45° FOV.
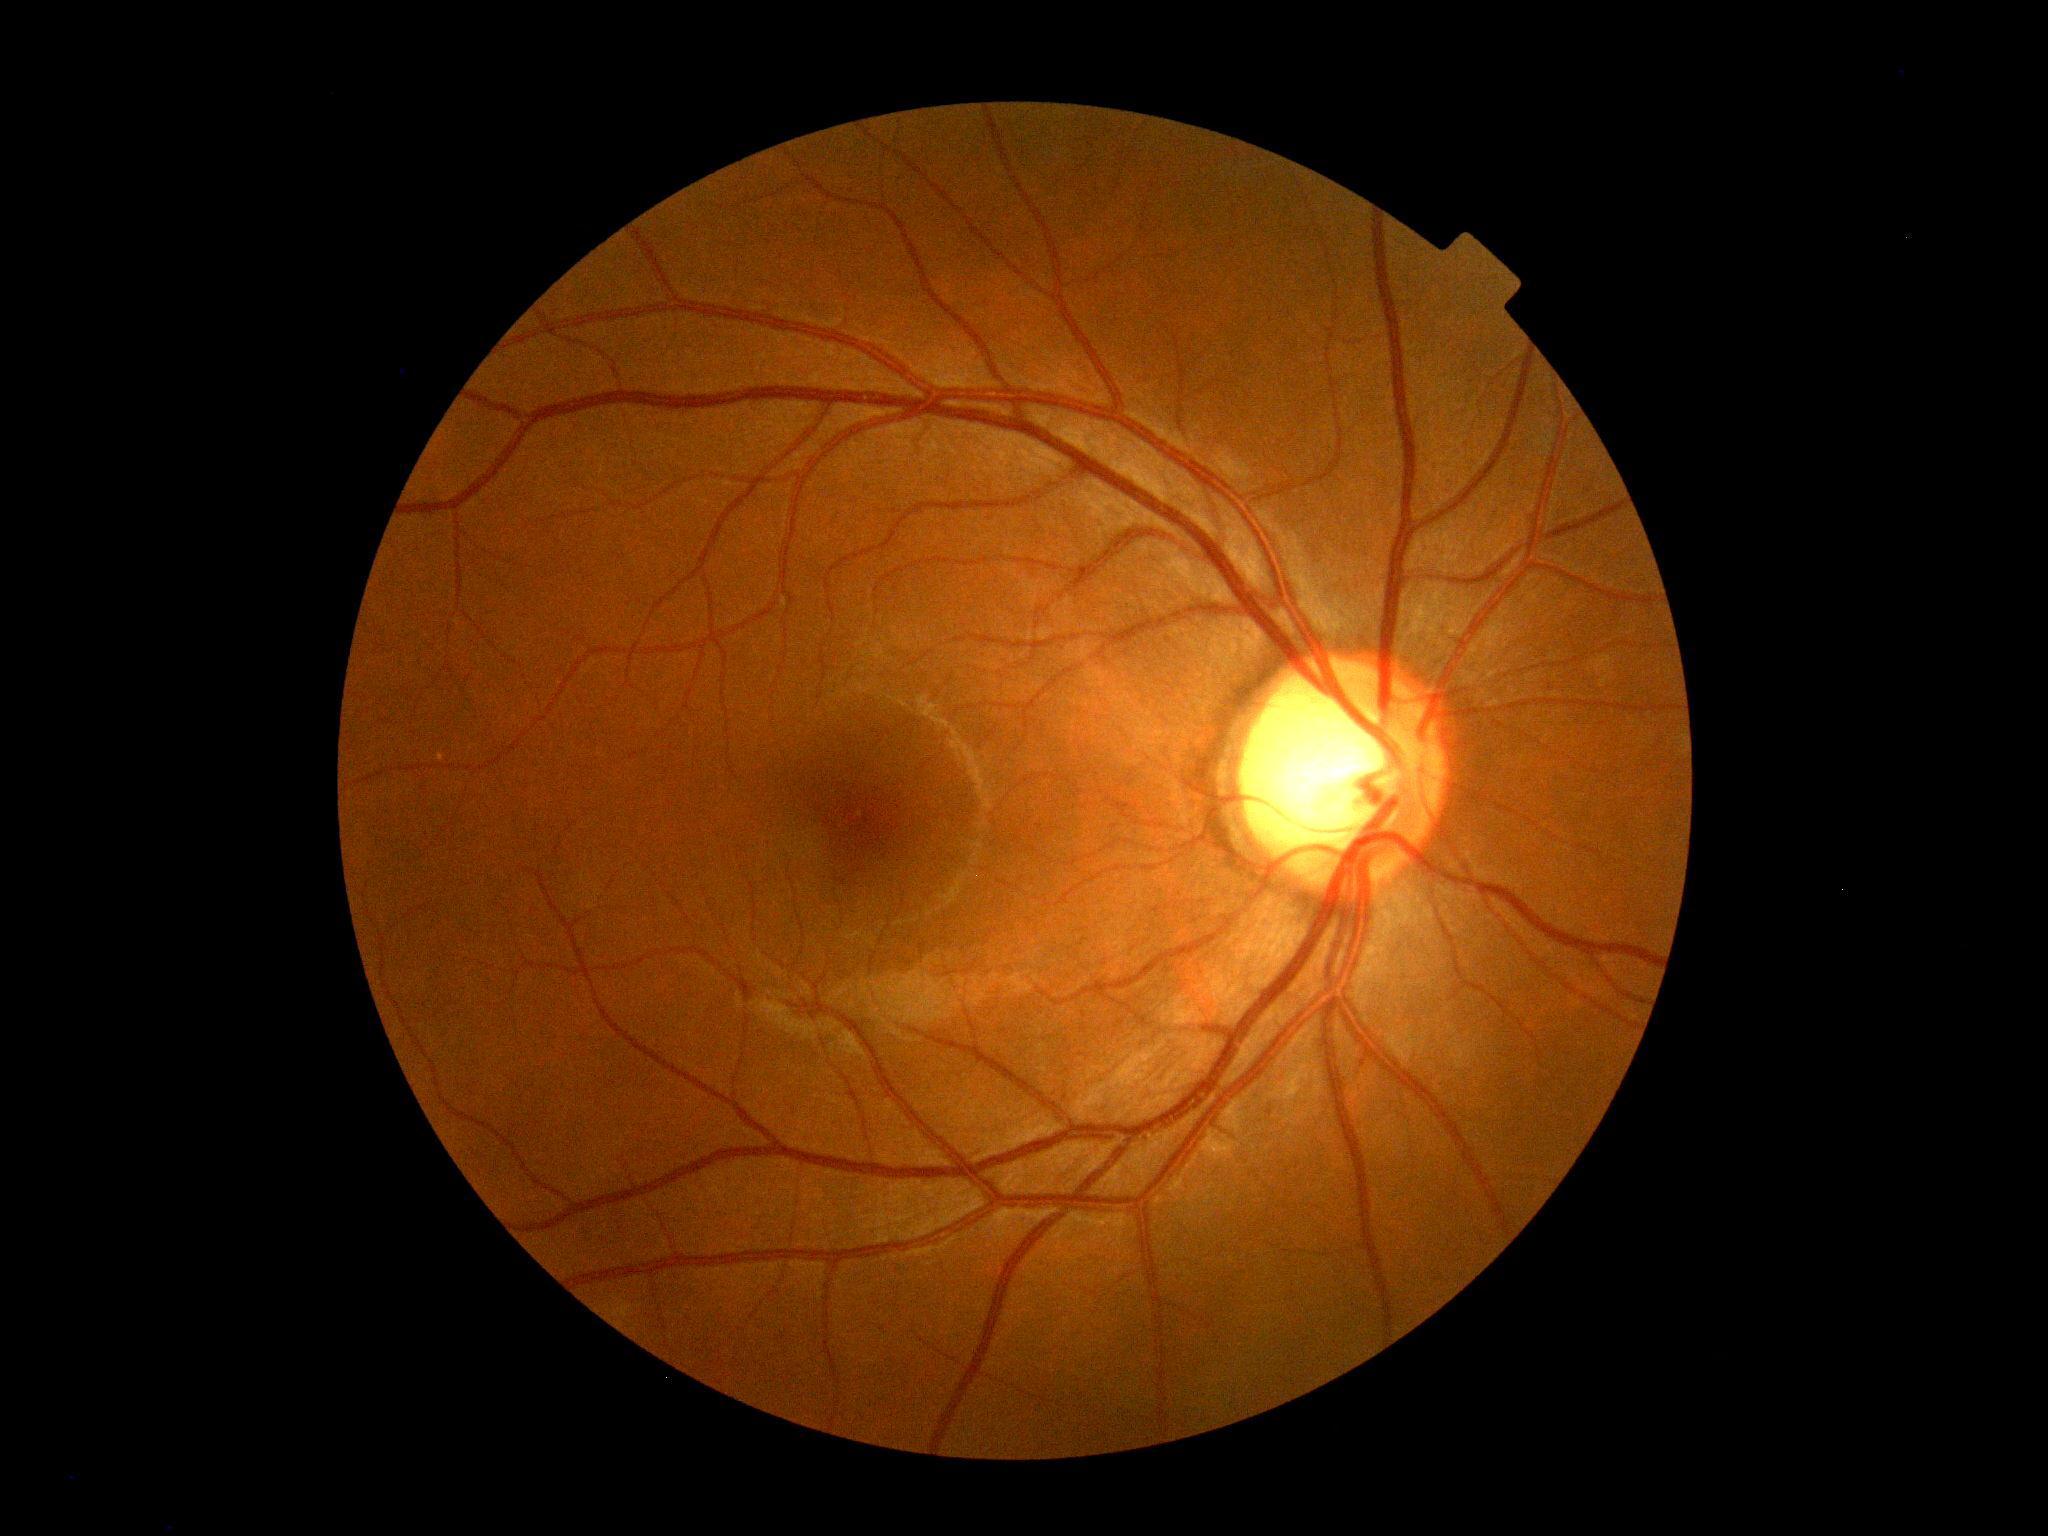

Diabetic retinopathy grade: 0 (no apparent retinopathy).